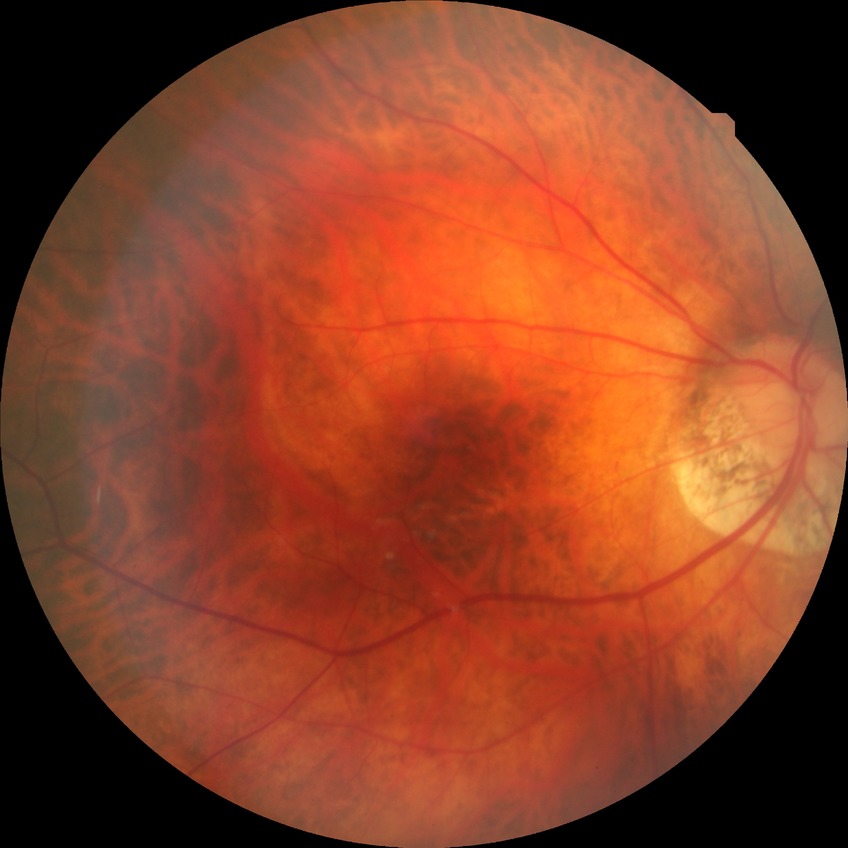
Modified Davis classification is no diabetic retinopathy.